CFP: 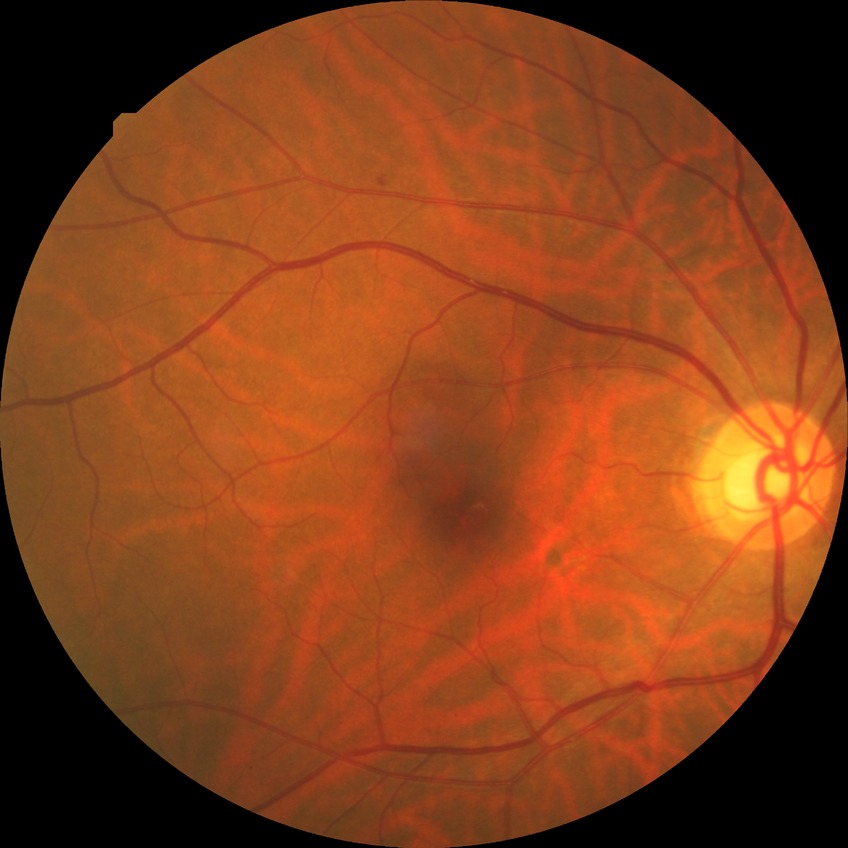
retinopathy stage=simple diabetic retinopathy.